Davis DR grading; nonmydriatic.
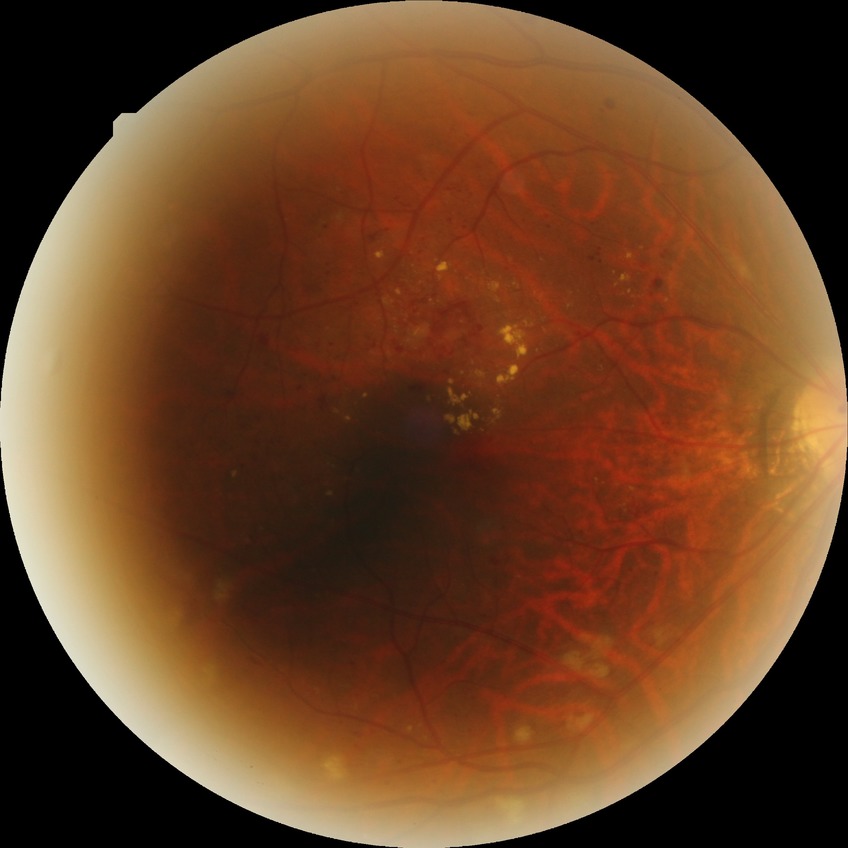 Diabetic retinopathy (DR) is pre-proliferative diabetic retinopathy (PPDR).